2048x1536px, FOV: 45 degrees
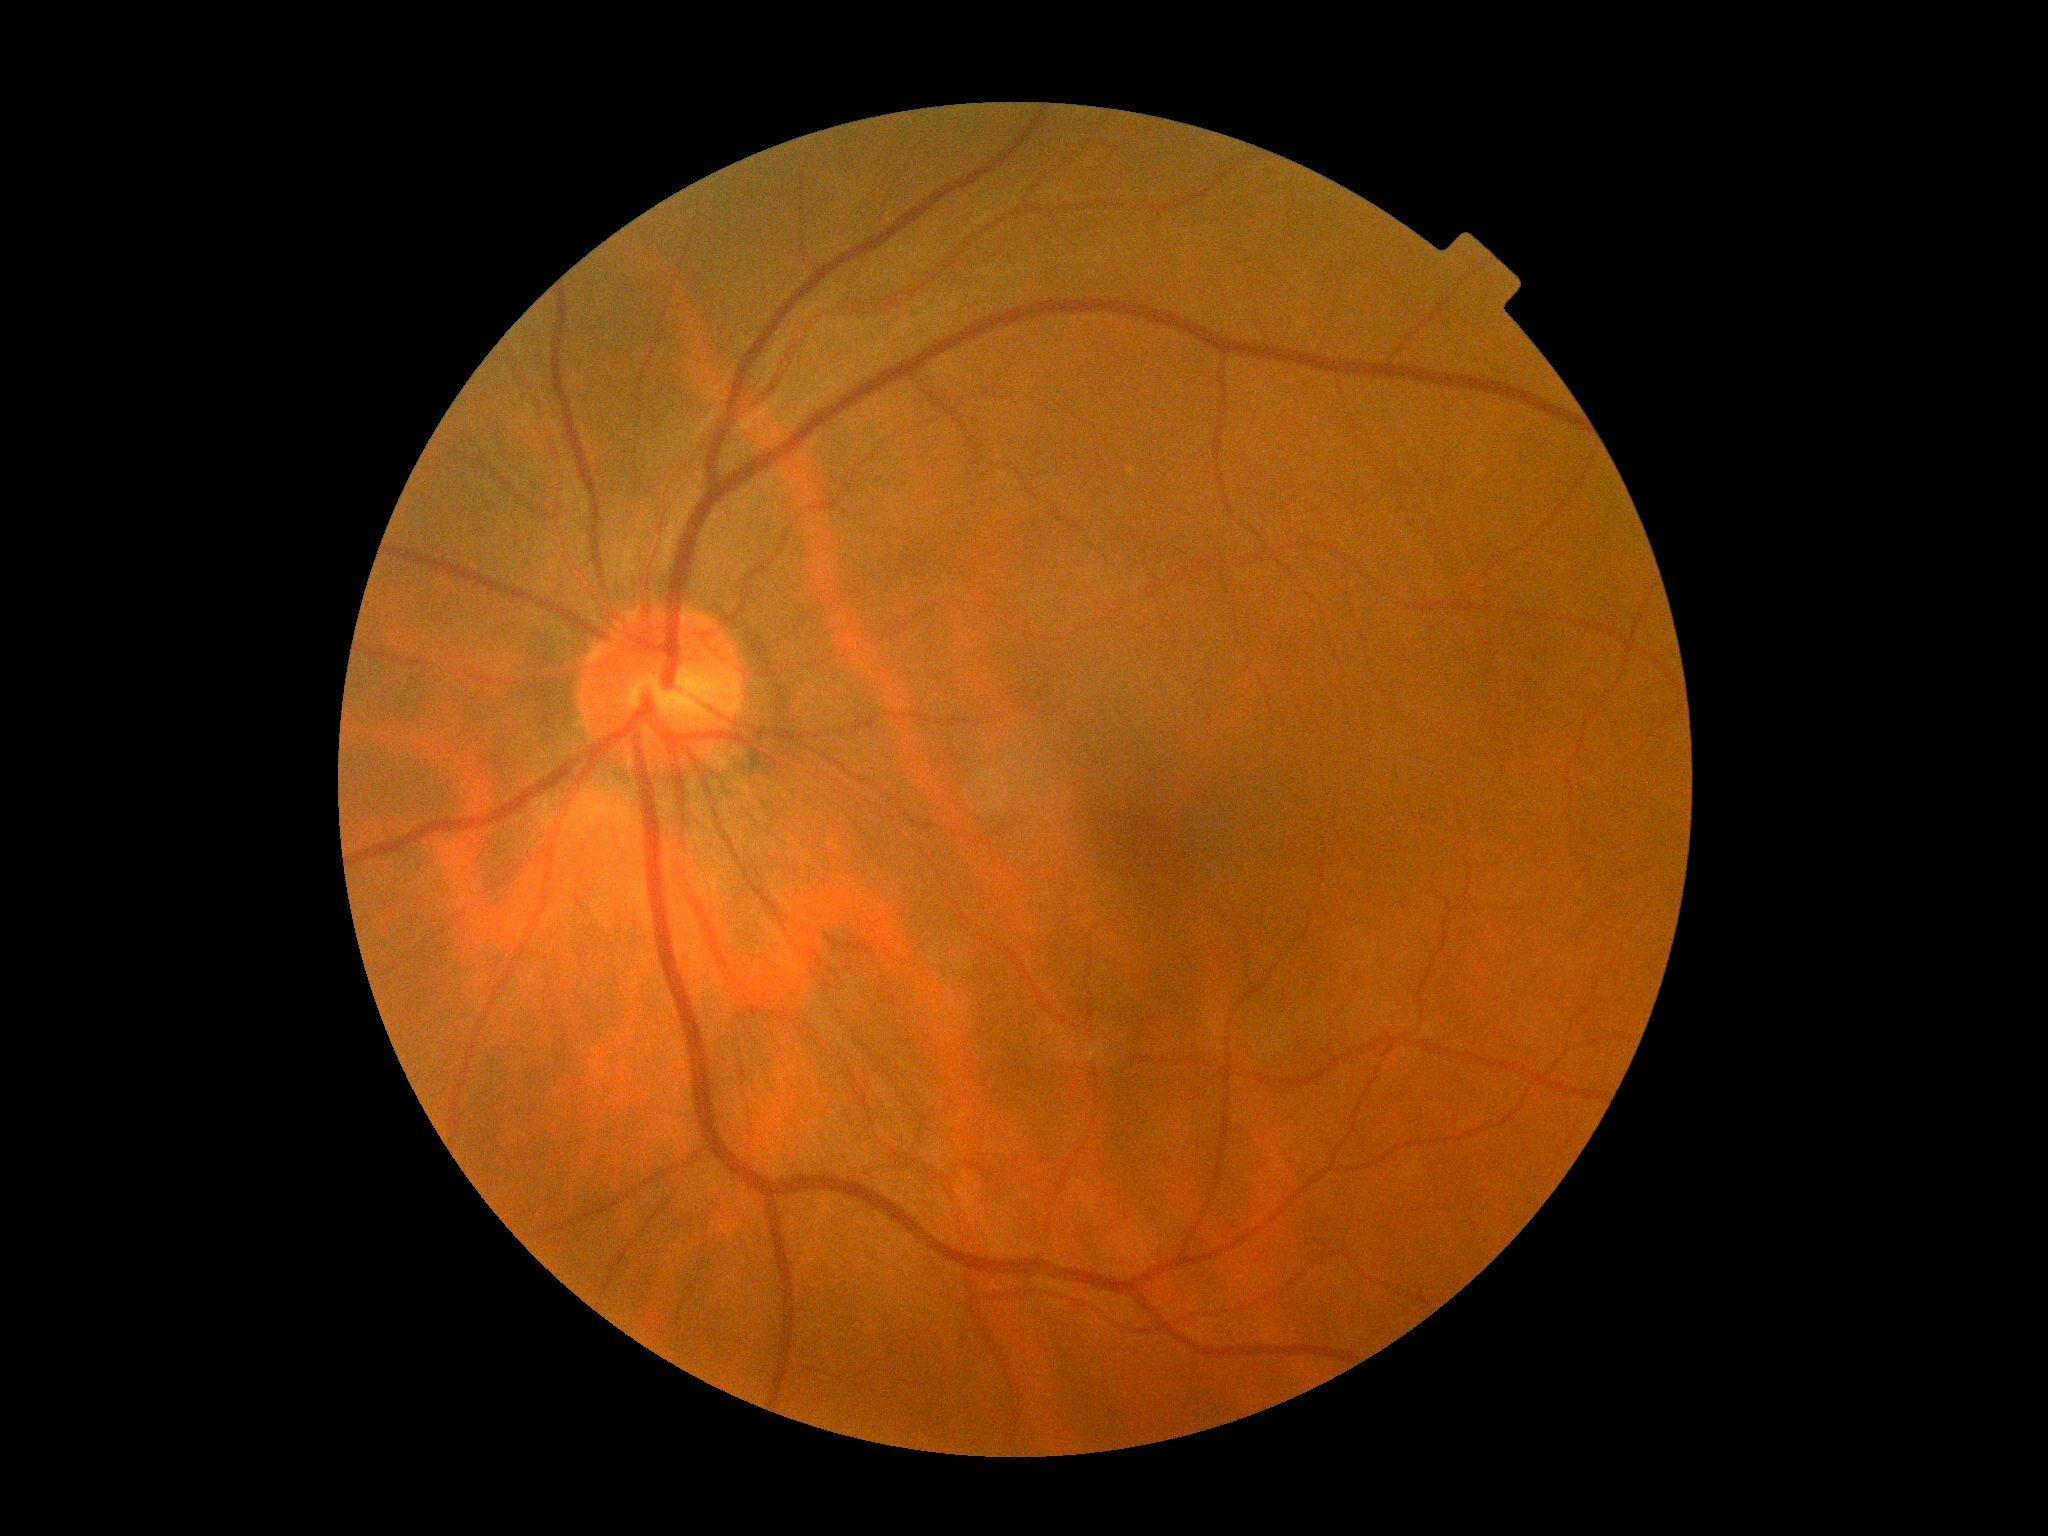

Diabetic retinopathy severity: no apparent diabetic retinopathy (grade 0).